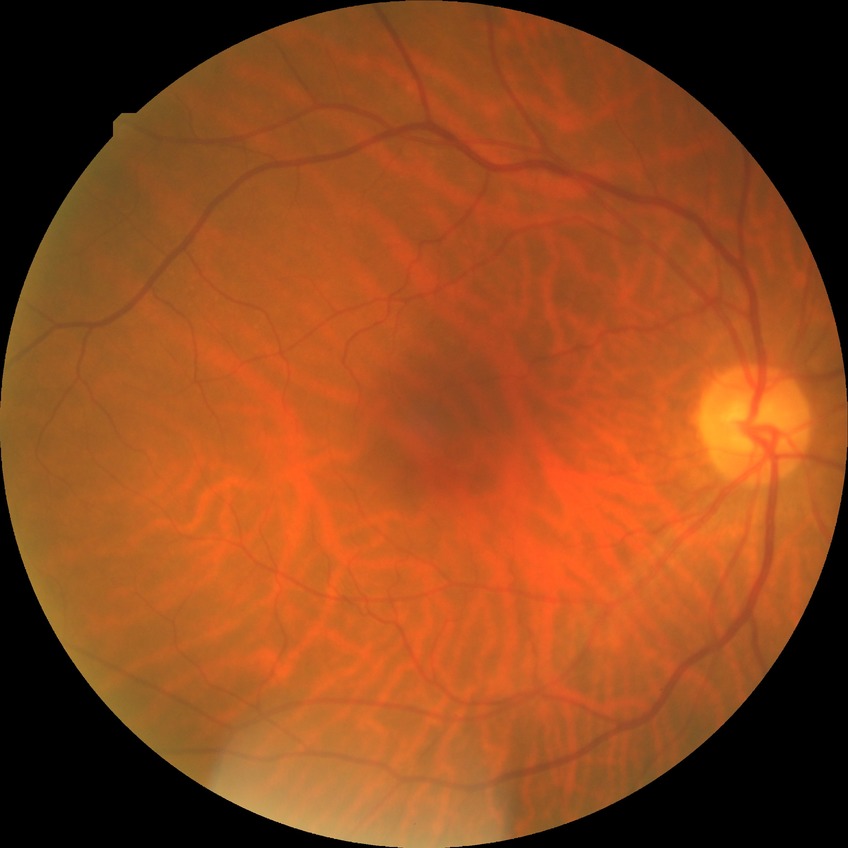 Retinopathy stage: no diabetic retinopathy.